Modified Davis classification: 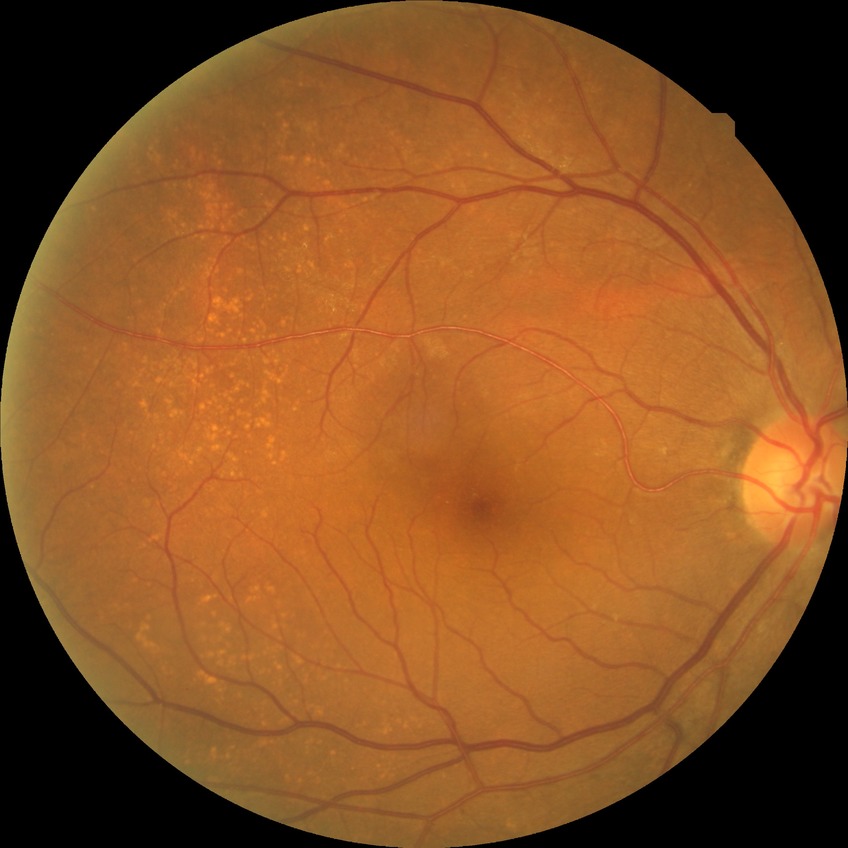 Diabetic retinopathy (DR): NDR (no diabetic retinopathy).